Image size 240x240: 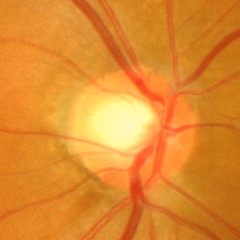 Q: Is glaucoma present?
A: Yes — advanced glaucomatous optic neuropathy.